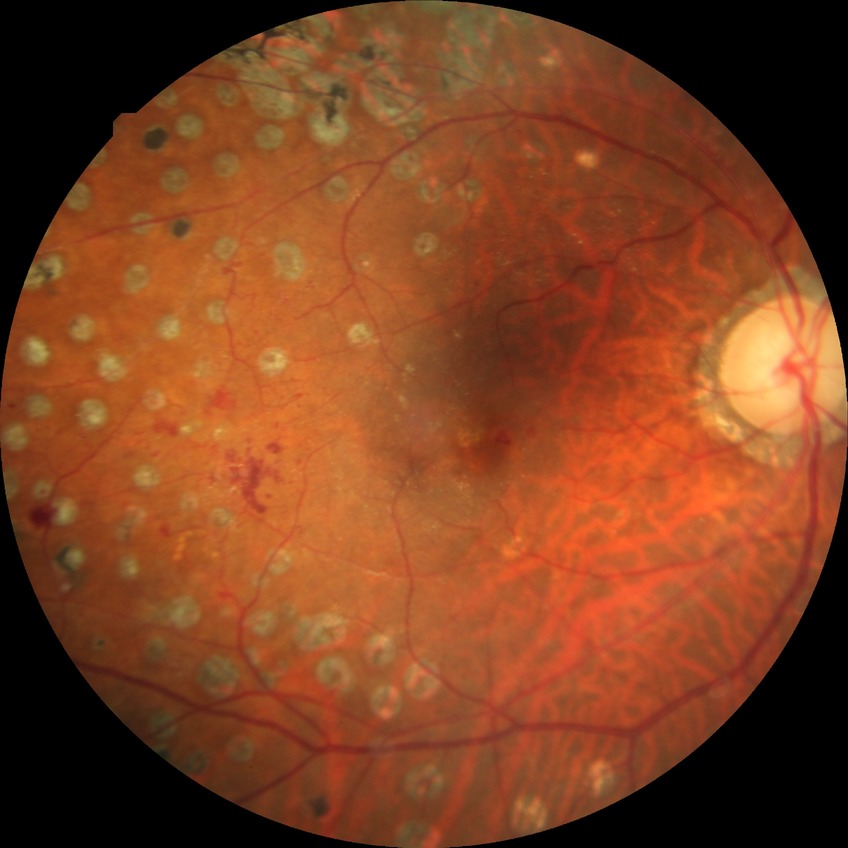
Diabetic retinopathy (DR) is proliferative diabetic retinopathy (PDR).